Wide-field fundus image from infant ROP screening
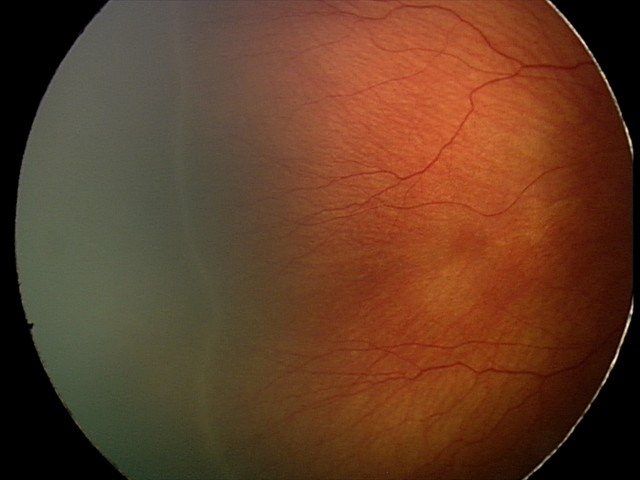
Assessment: retinopathy of prematurity stage 2.